640x480px. Pediatric retinal photograph (wide-field). Clarity RetCam 3, 130° FOV.
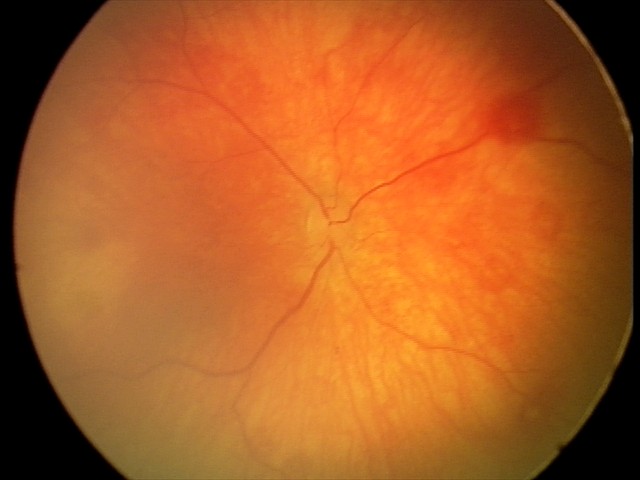

Screening diagnosis: physiological finding.